1932x1932. 50° field of view. Dilated-pupil acquisition: 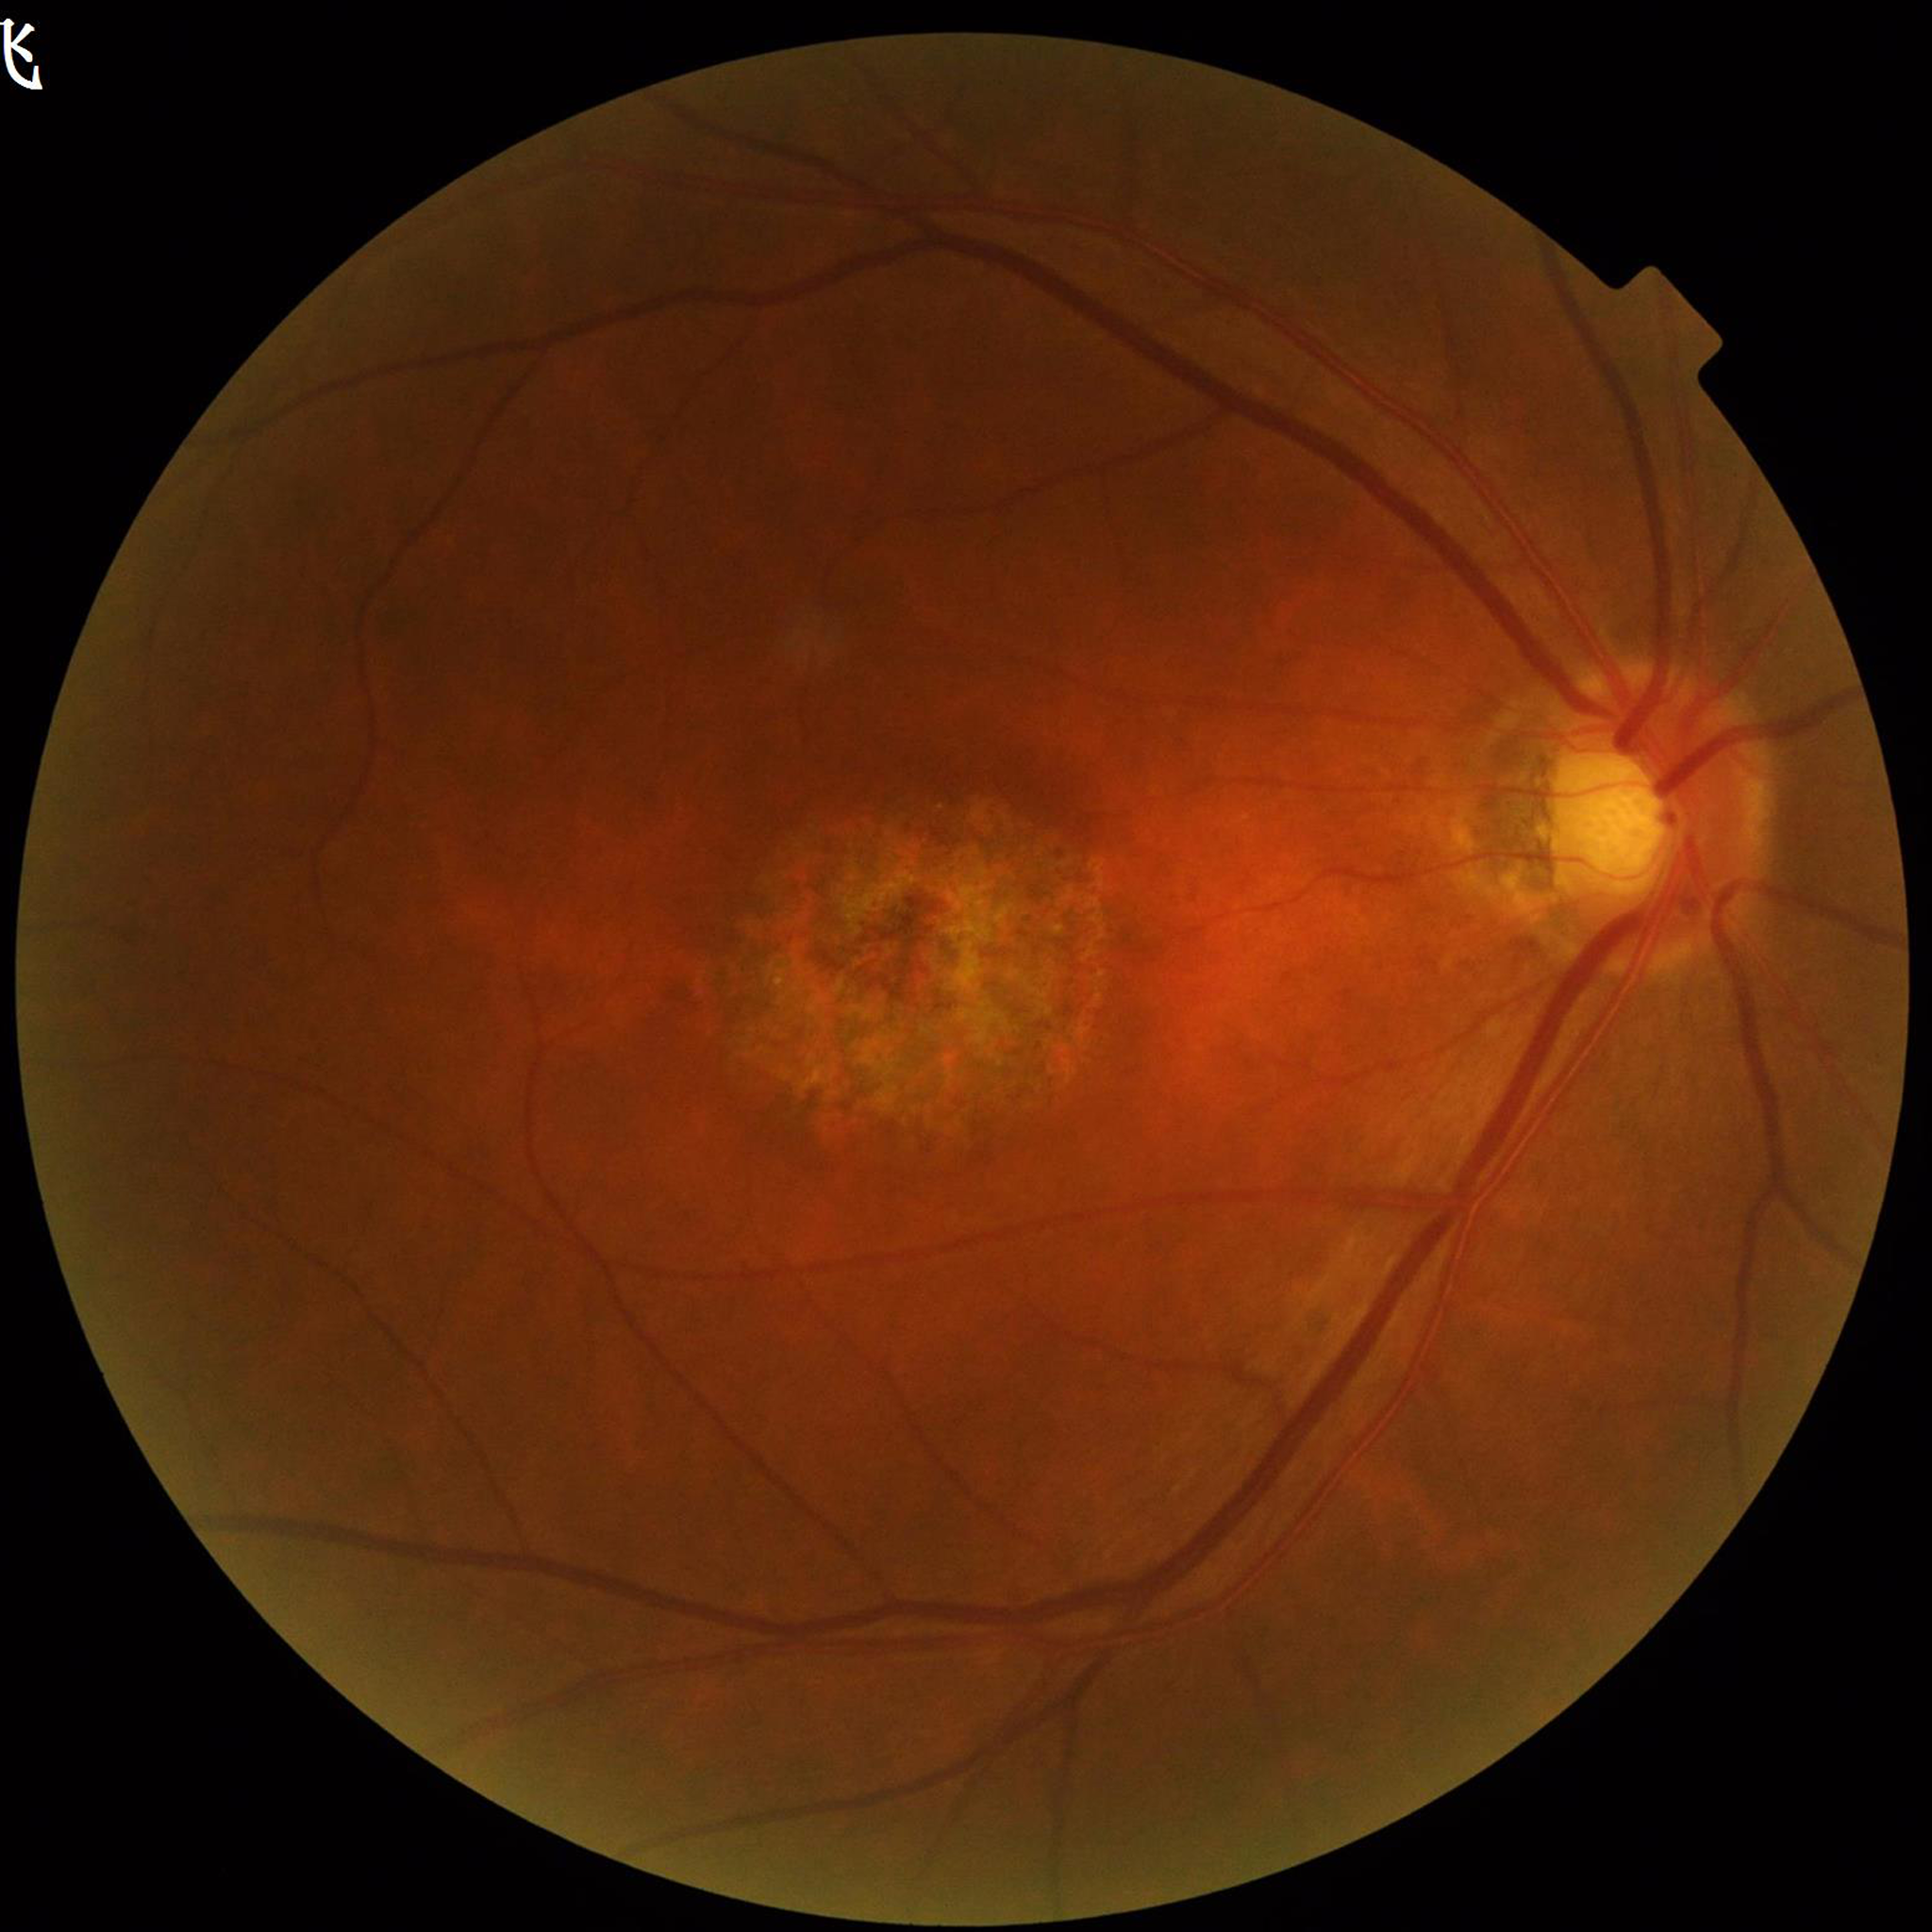

Image quality: good
Diagnosis: age-related macular degeneration